Retinal fundus photograph; image size 1504x1000: 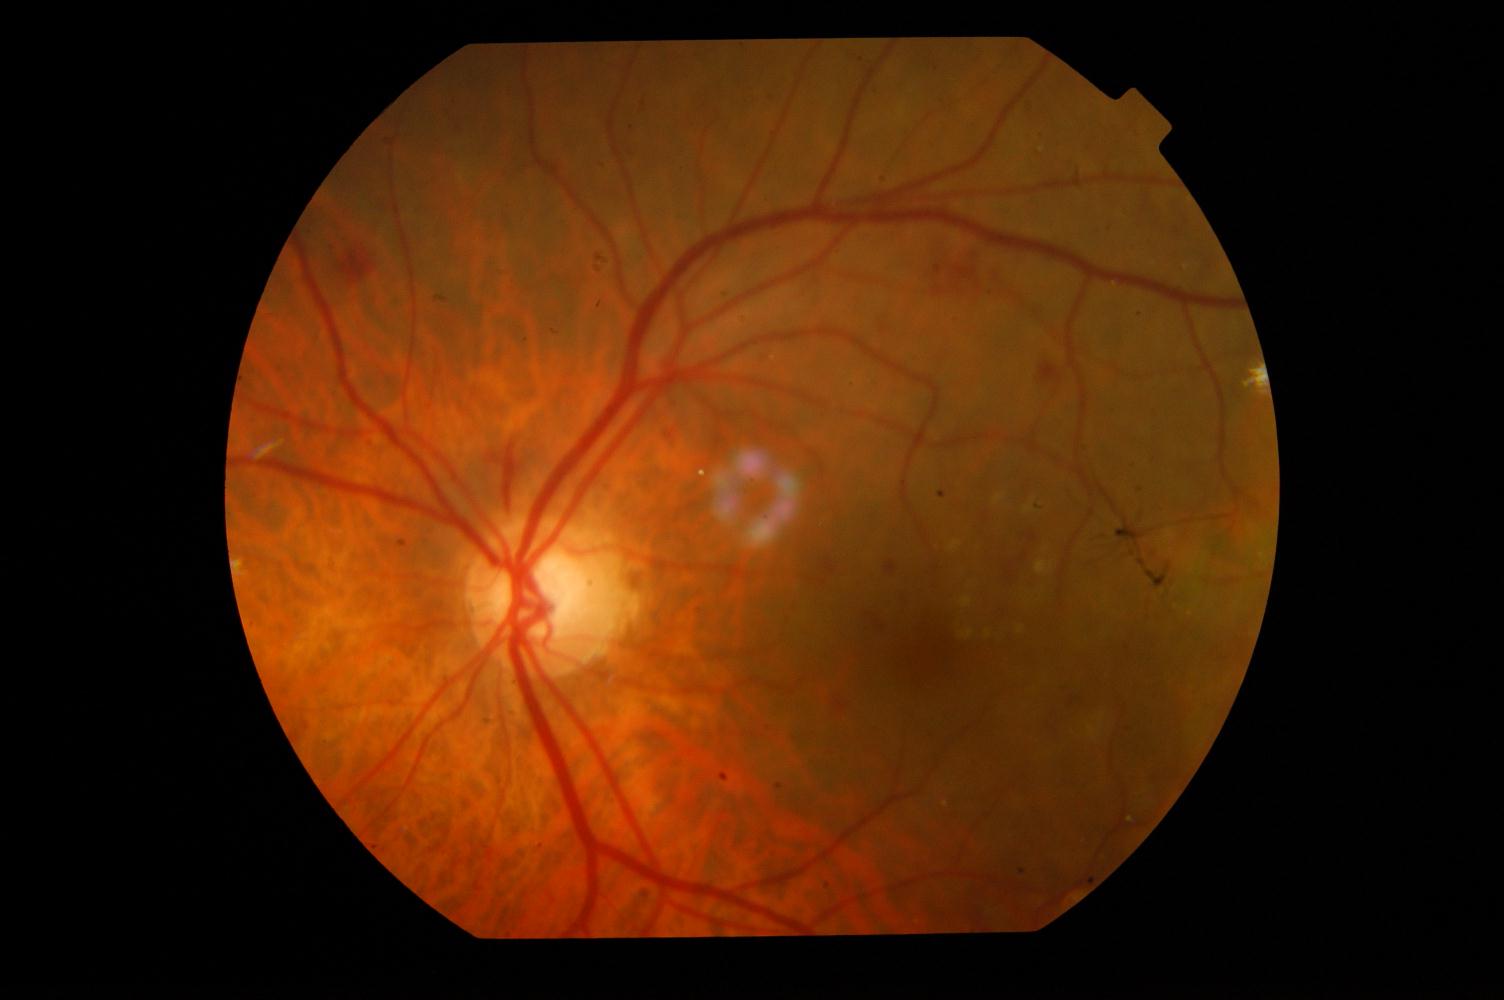
The image shows diabetic retinopathy.